NIDEK AFC-230 · no pharmacologic dilation — 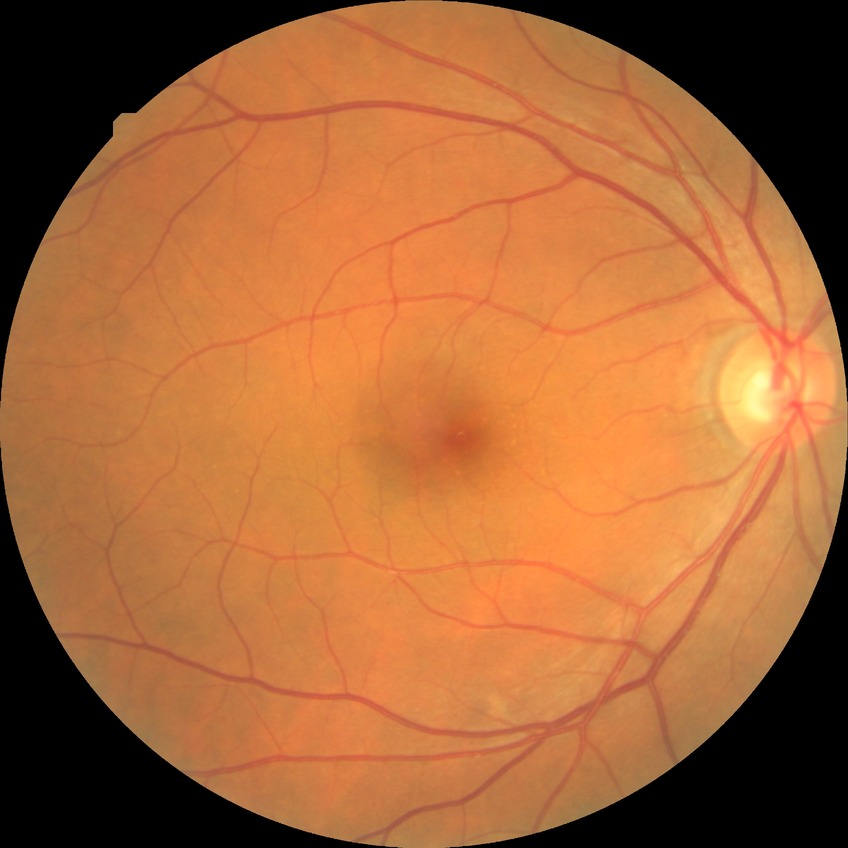
Retinopathy stage: no diabetic retinopathy.